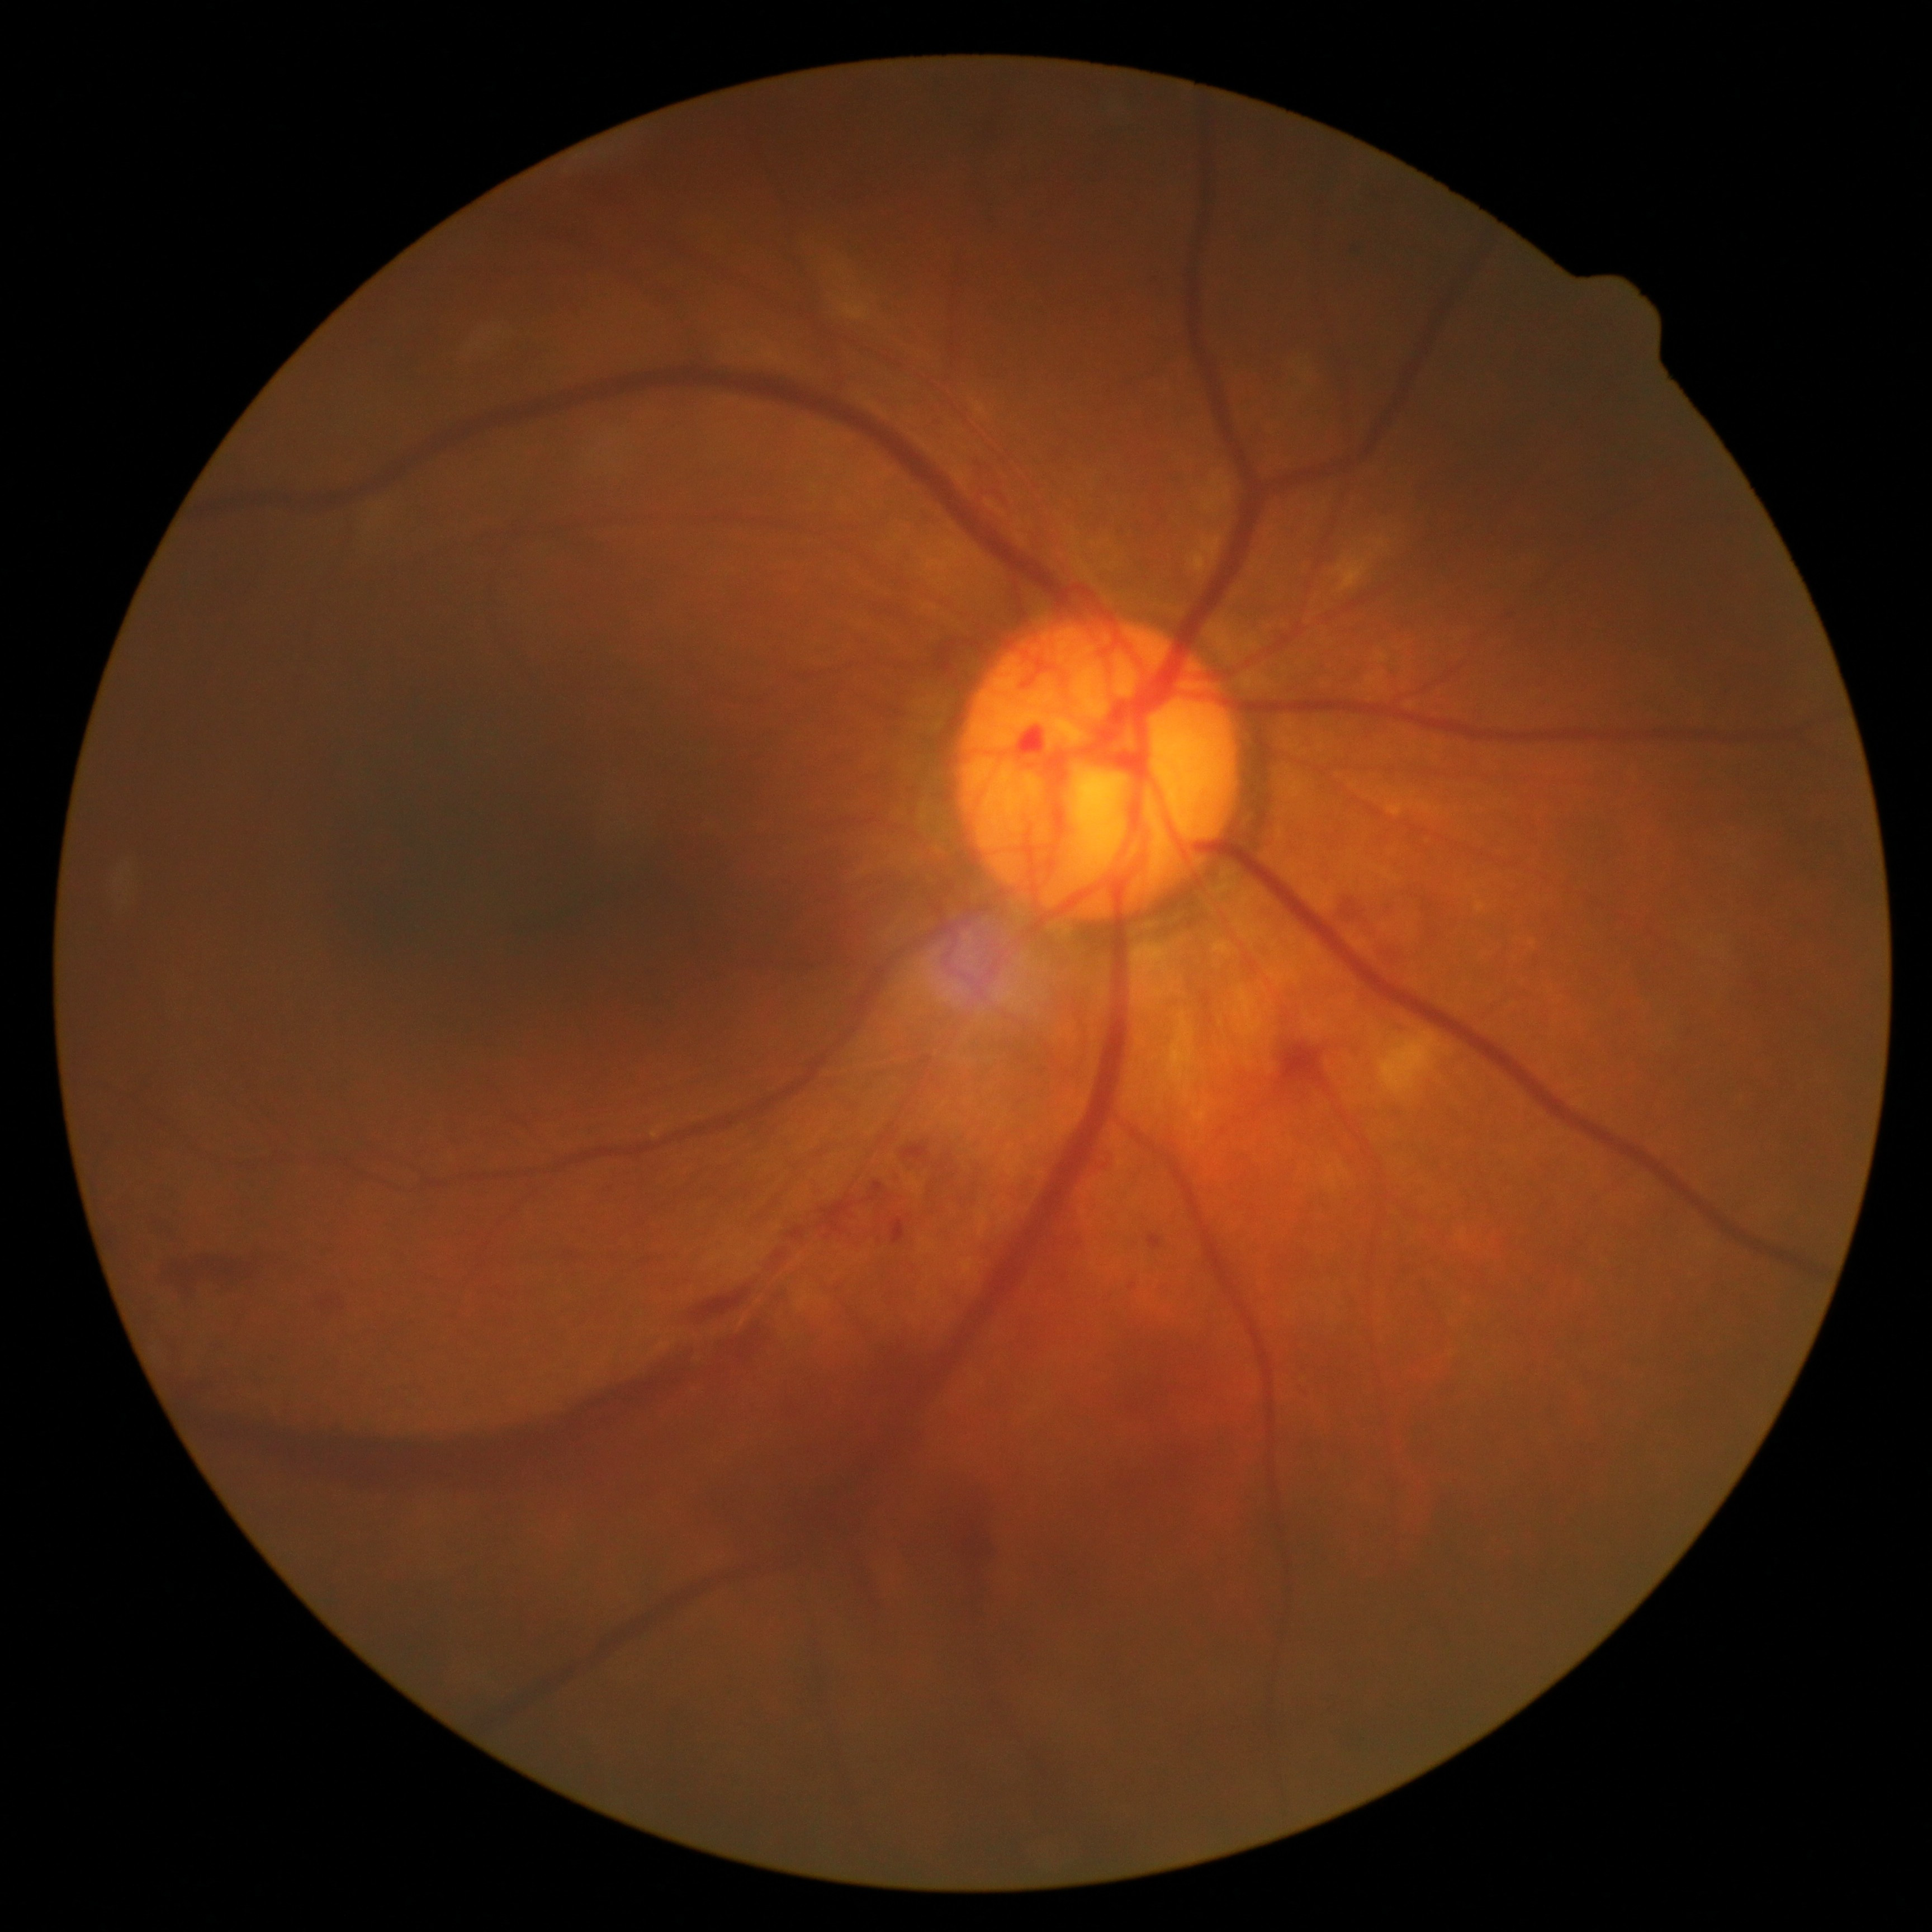
diabetic retinopathy (DR): grade 4